Retinal fundus photograph
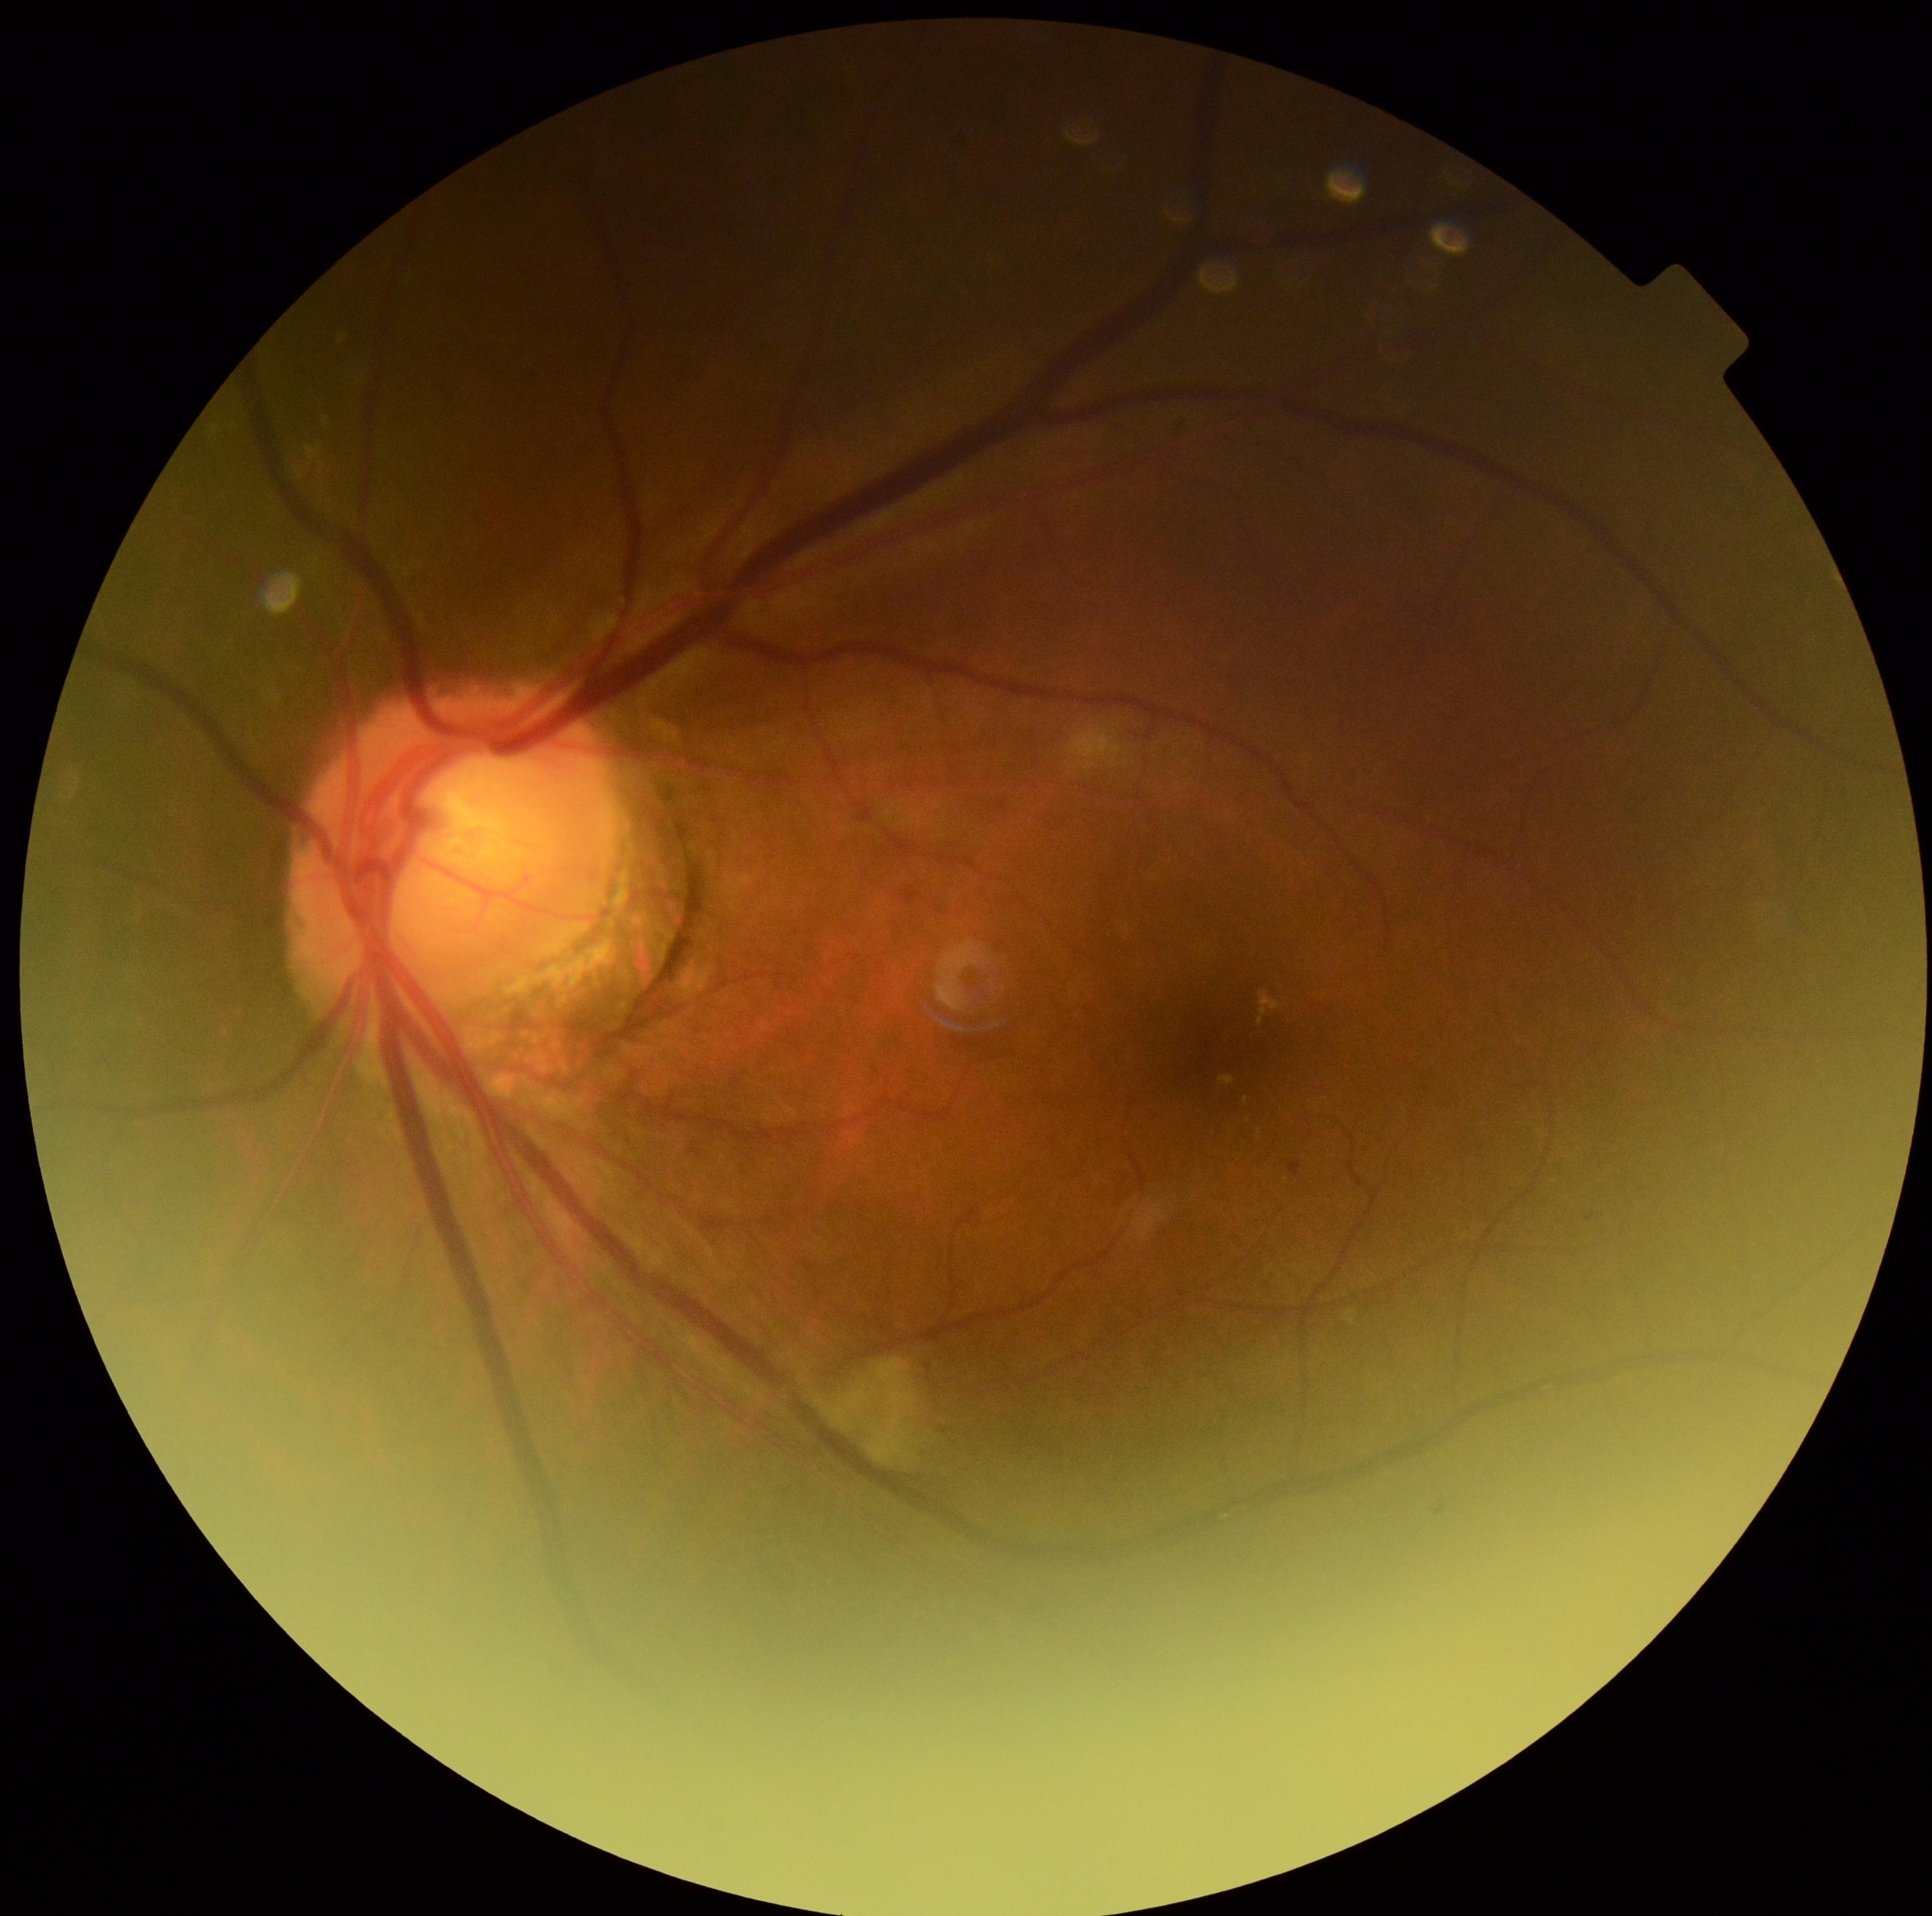
DR=moderate NPDR (grade 2).